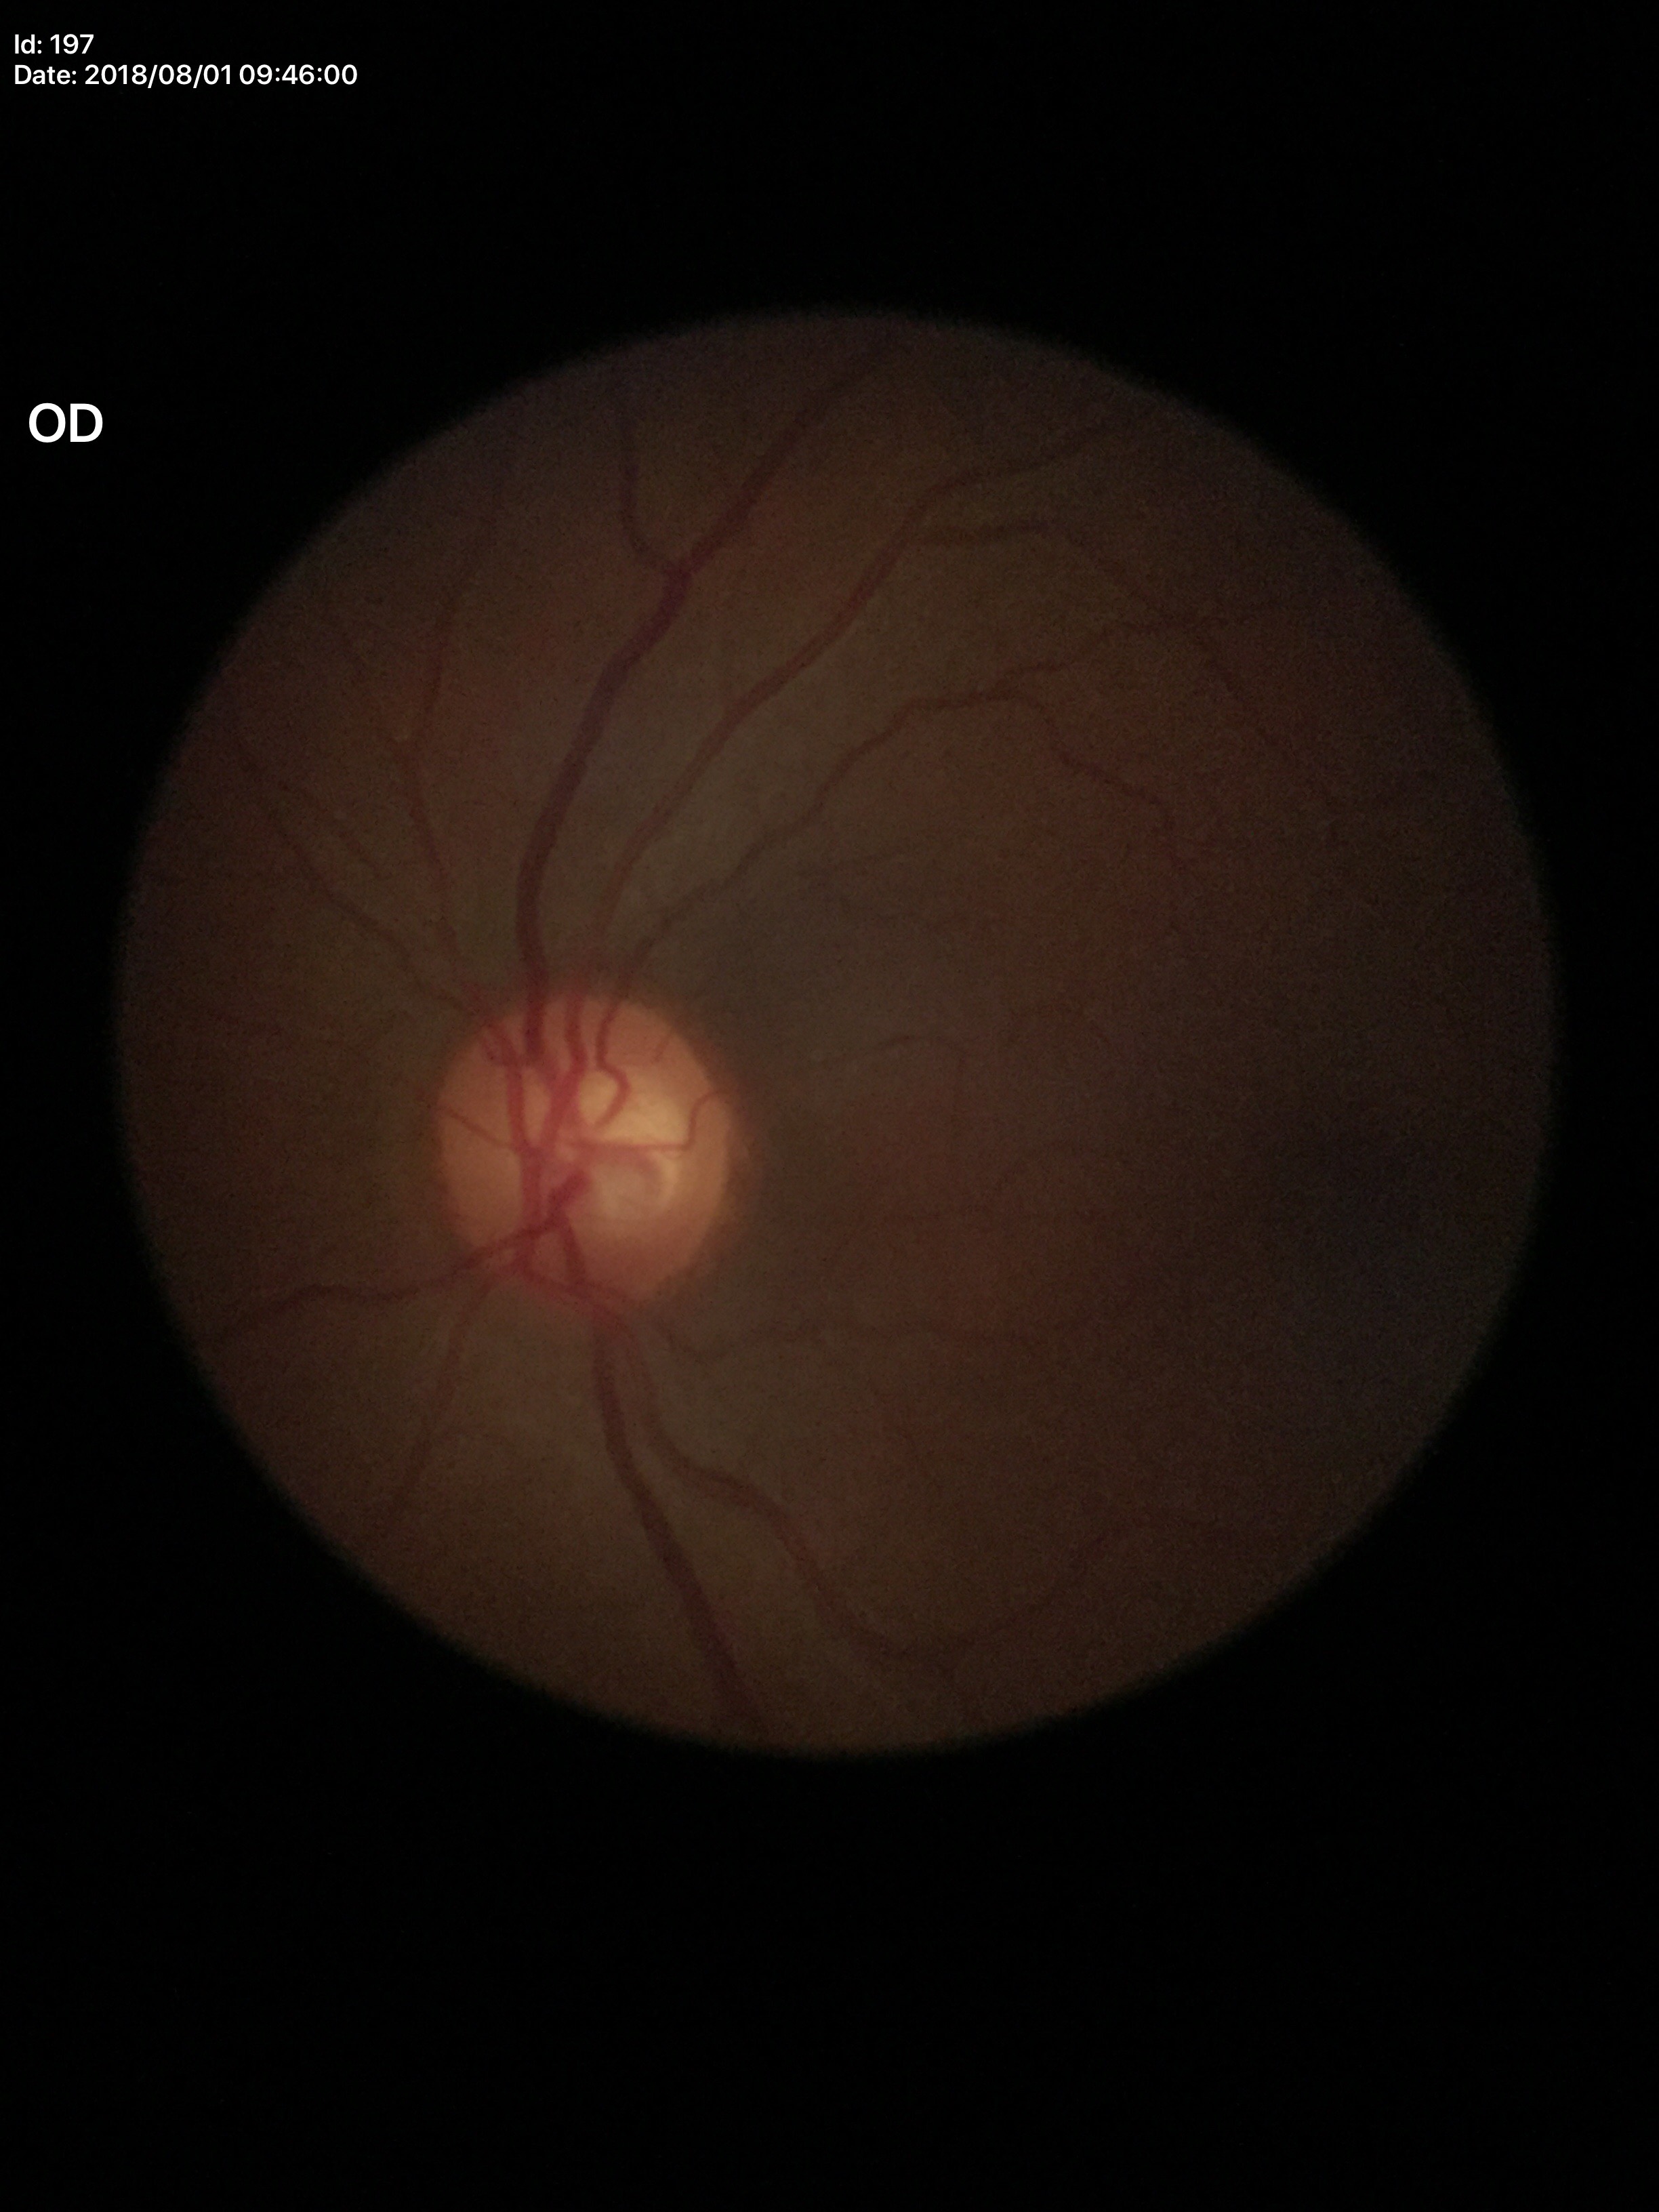
VCDR=0.57 | Glaucoma decision=no suspicious findings (1/5 graders called glaucoma suspect)